2212 by 1659 pixels; fundus photo taken with a portable handheld camera.
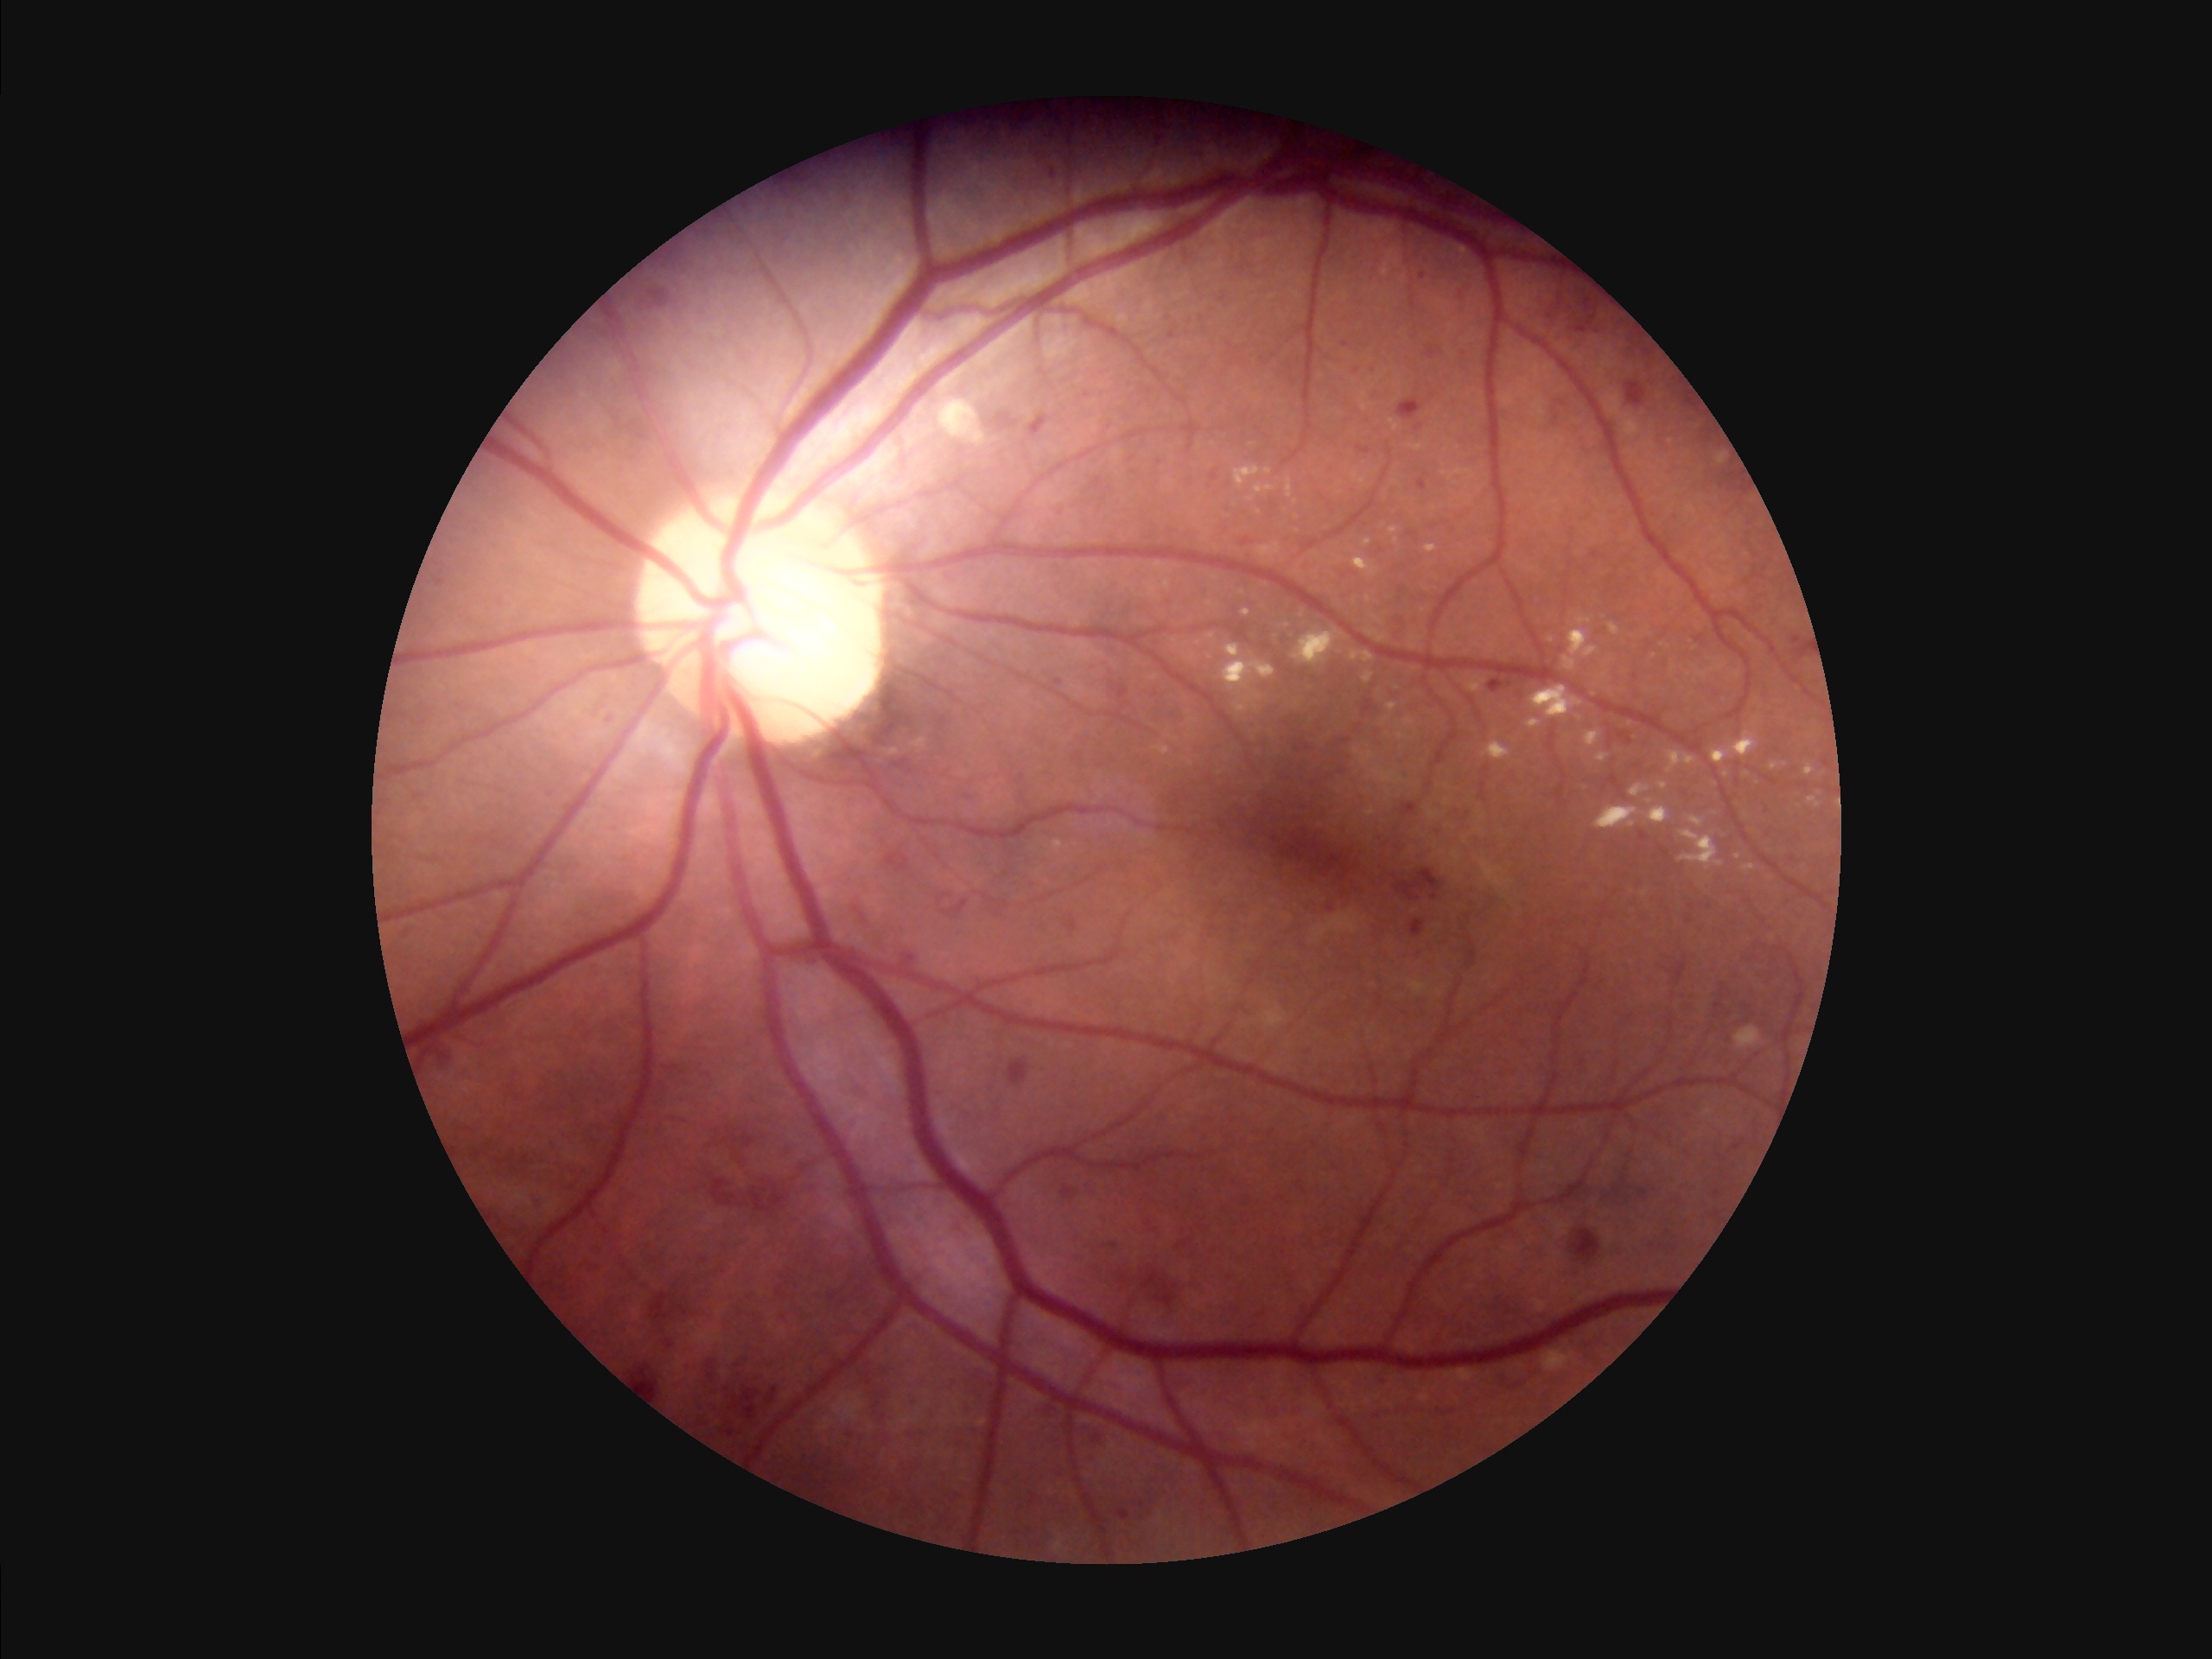
The image is clear. Illumination and color balance are good. Adequate contrast for distinguishing structures. Overall image quality is good.